Fundus photo.
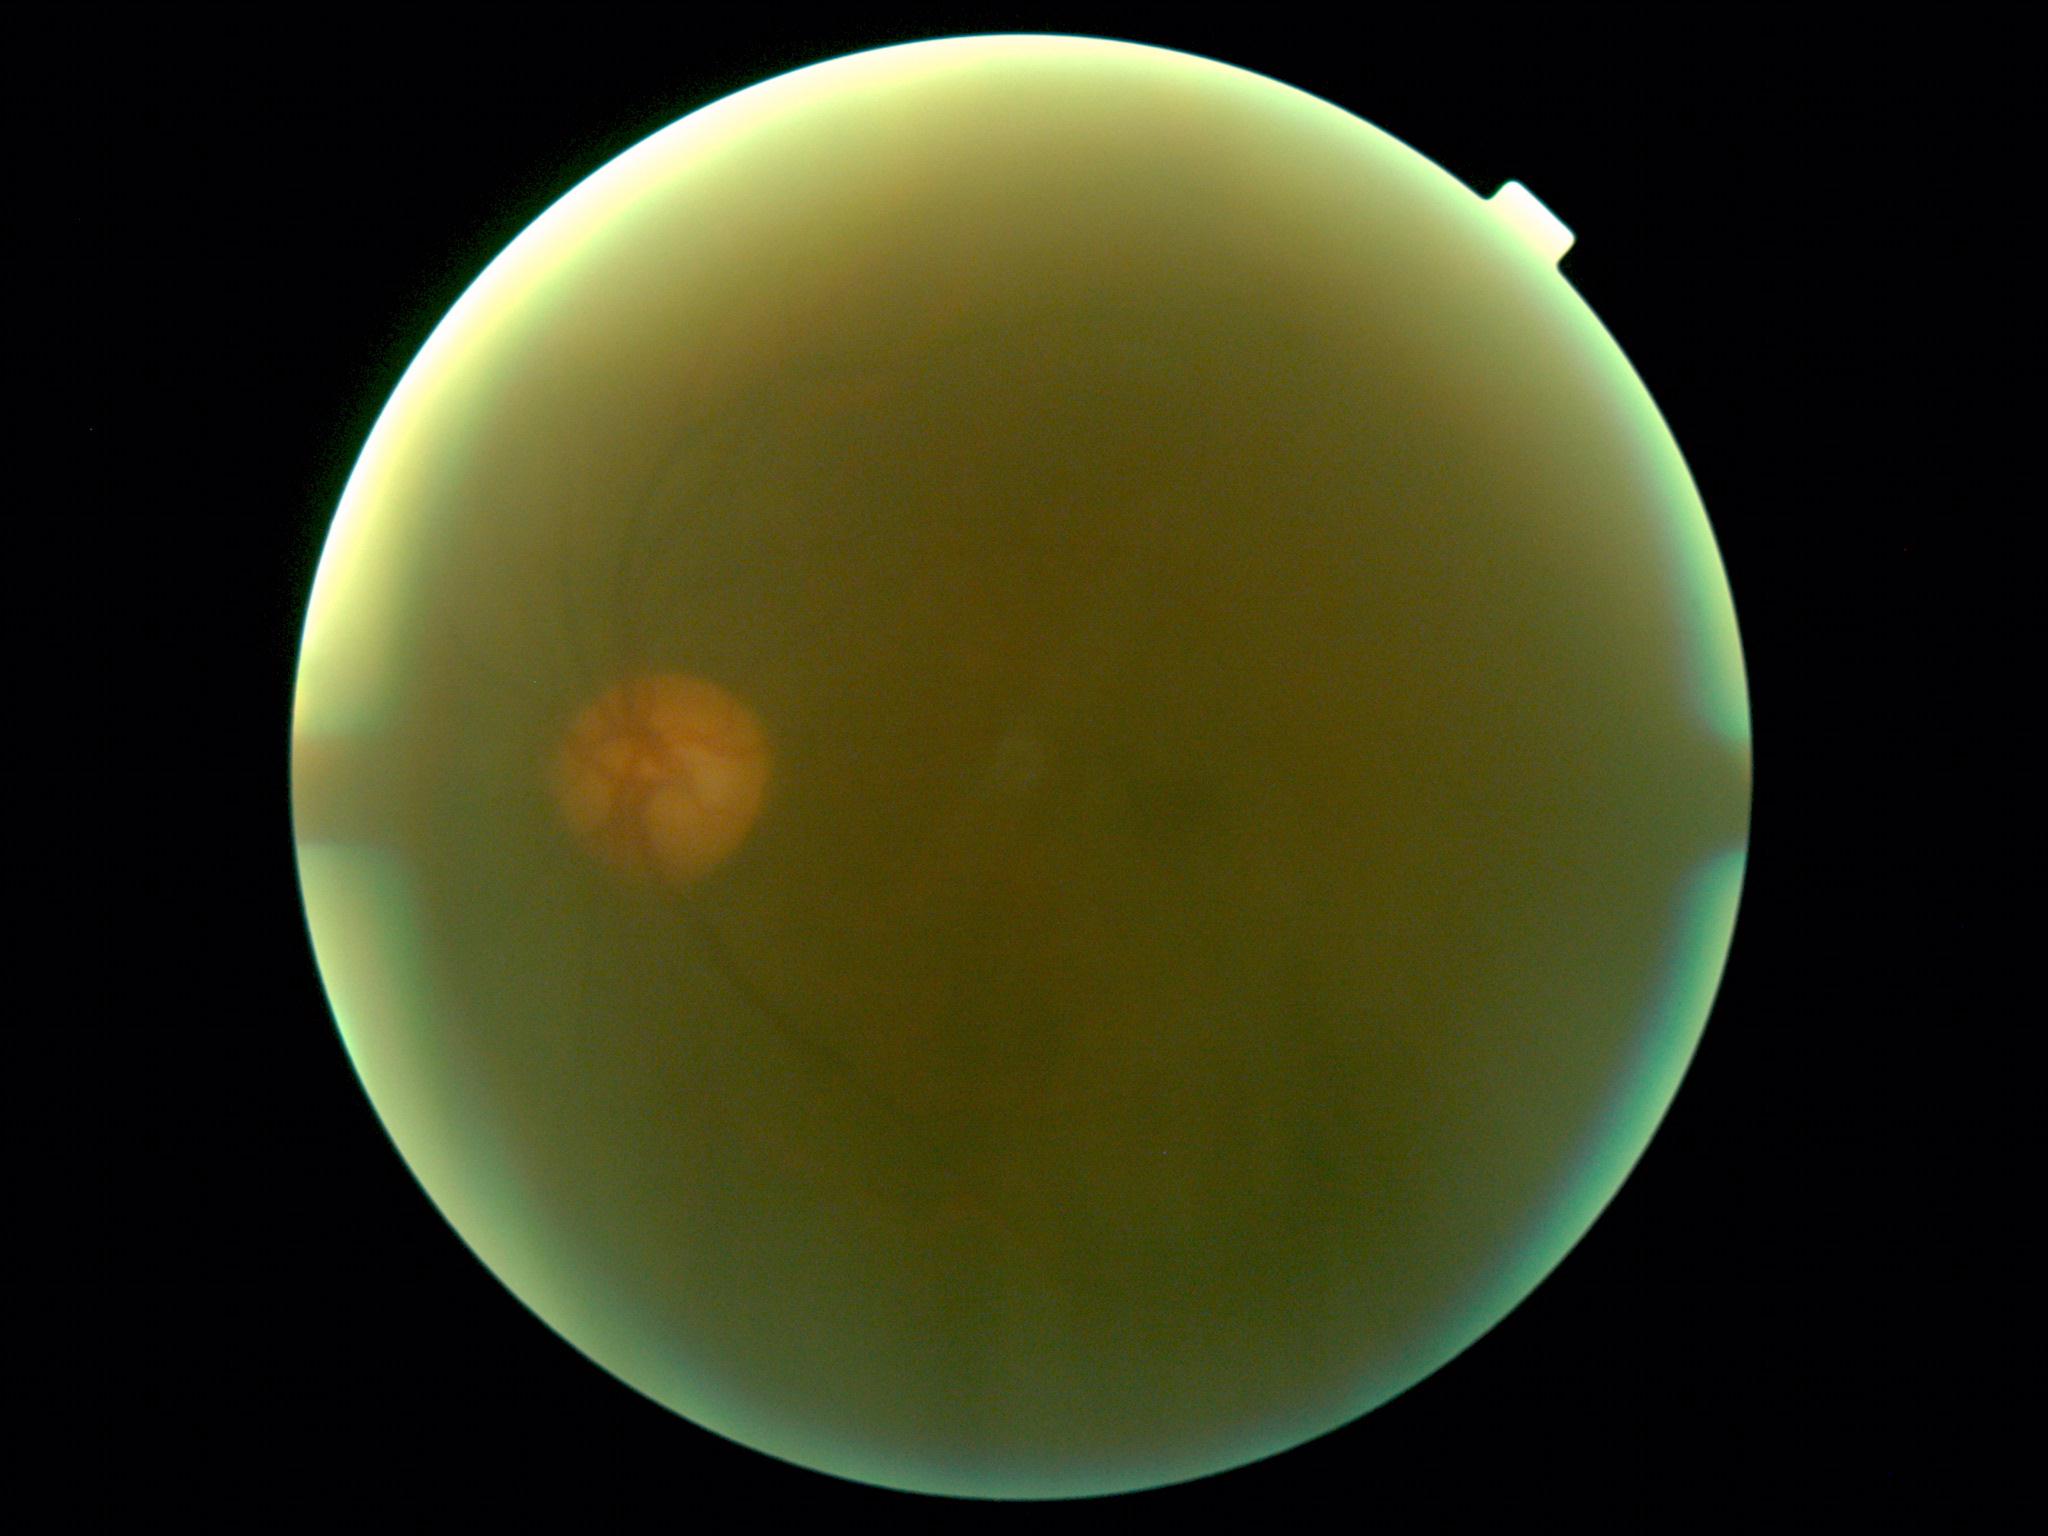

  dr_grade: ungradable
  quality: insufficient